Image size 848x848, fundus photo — 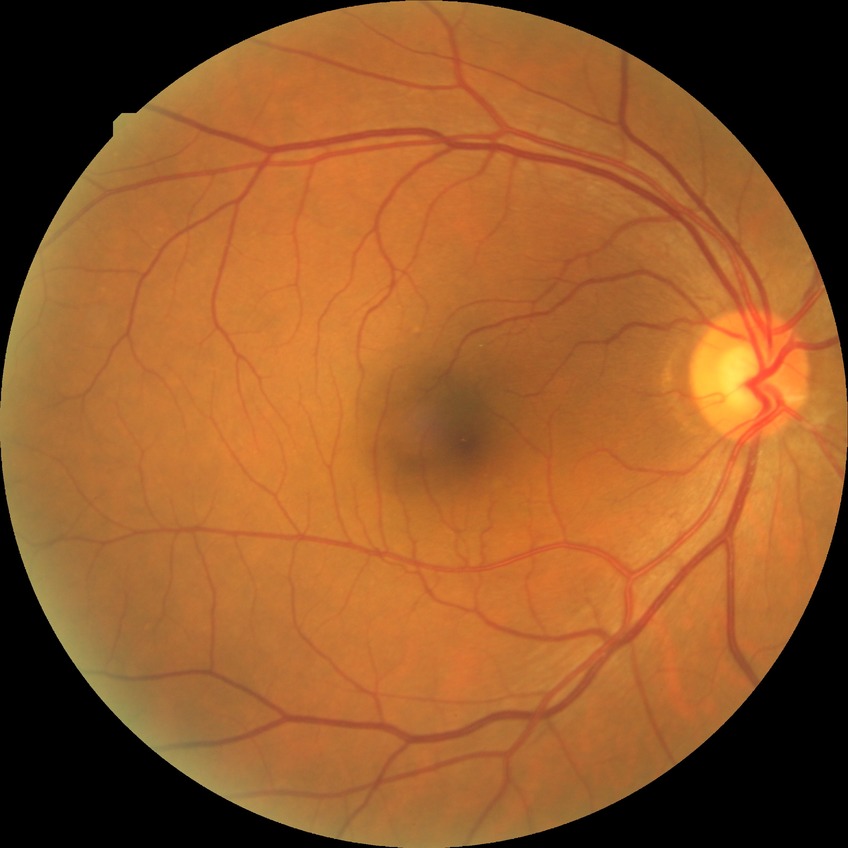
DR stage: NDR, DR impression: negative for DR.